DR severity per modified Davis staging: 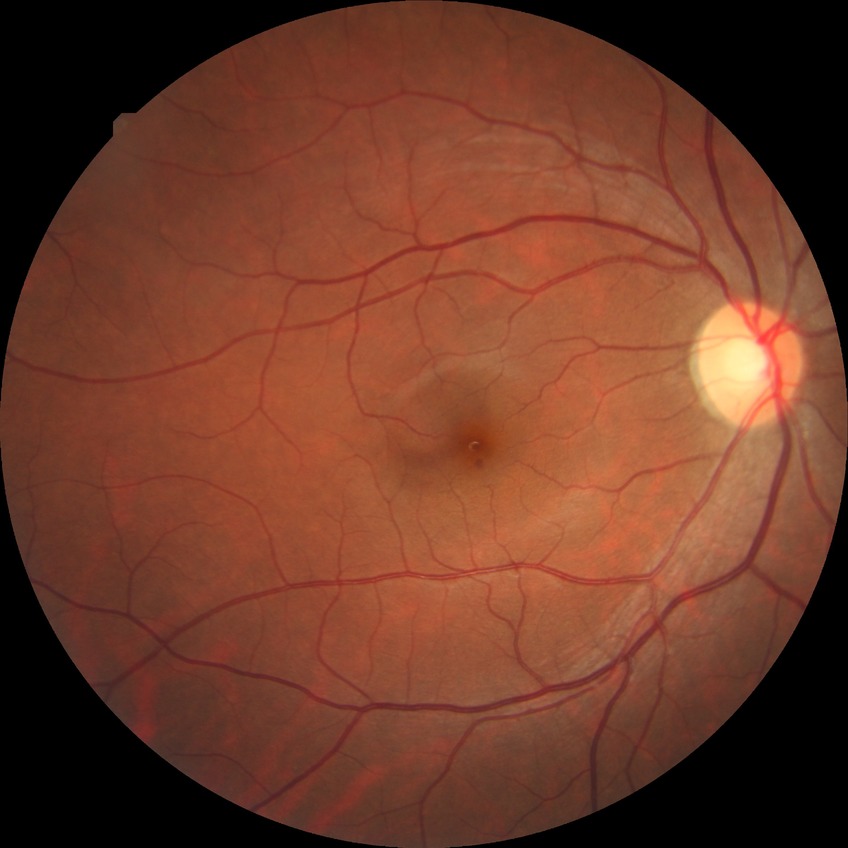

DR is NDR.